Camera: NIDEK AFC-230; 45° FOV:
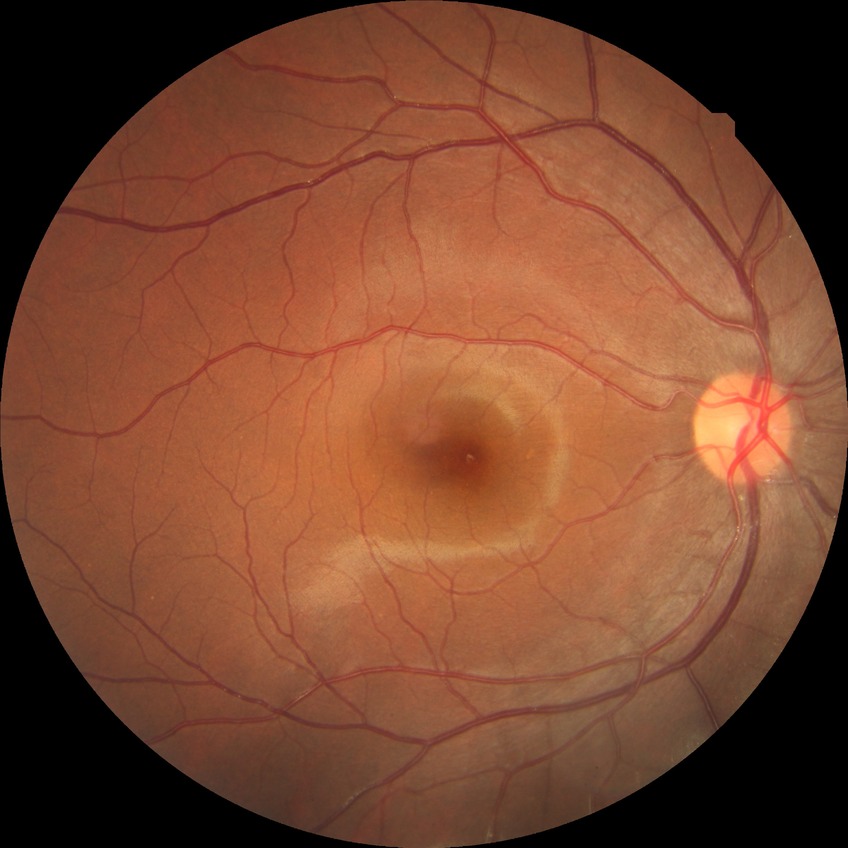

DR stage: NDR.